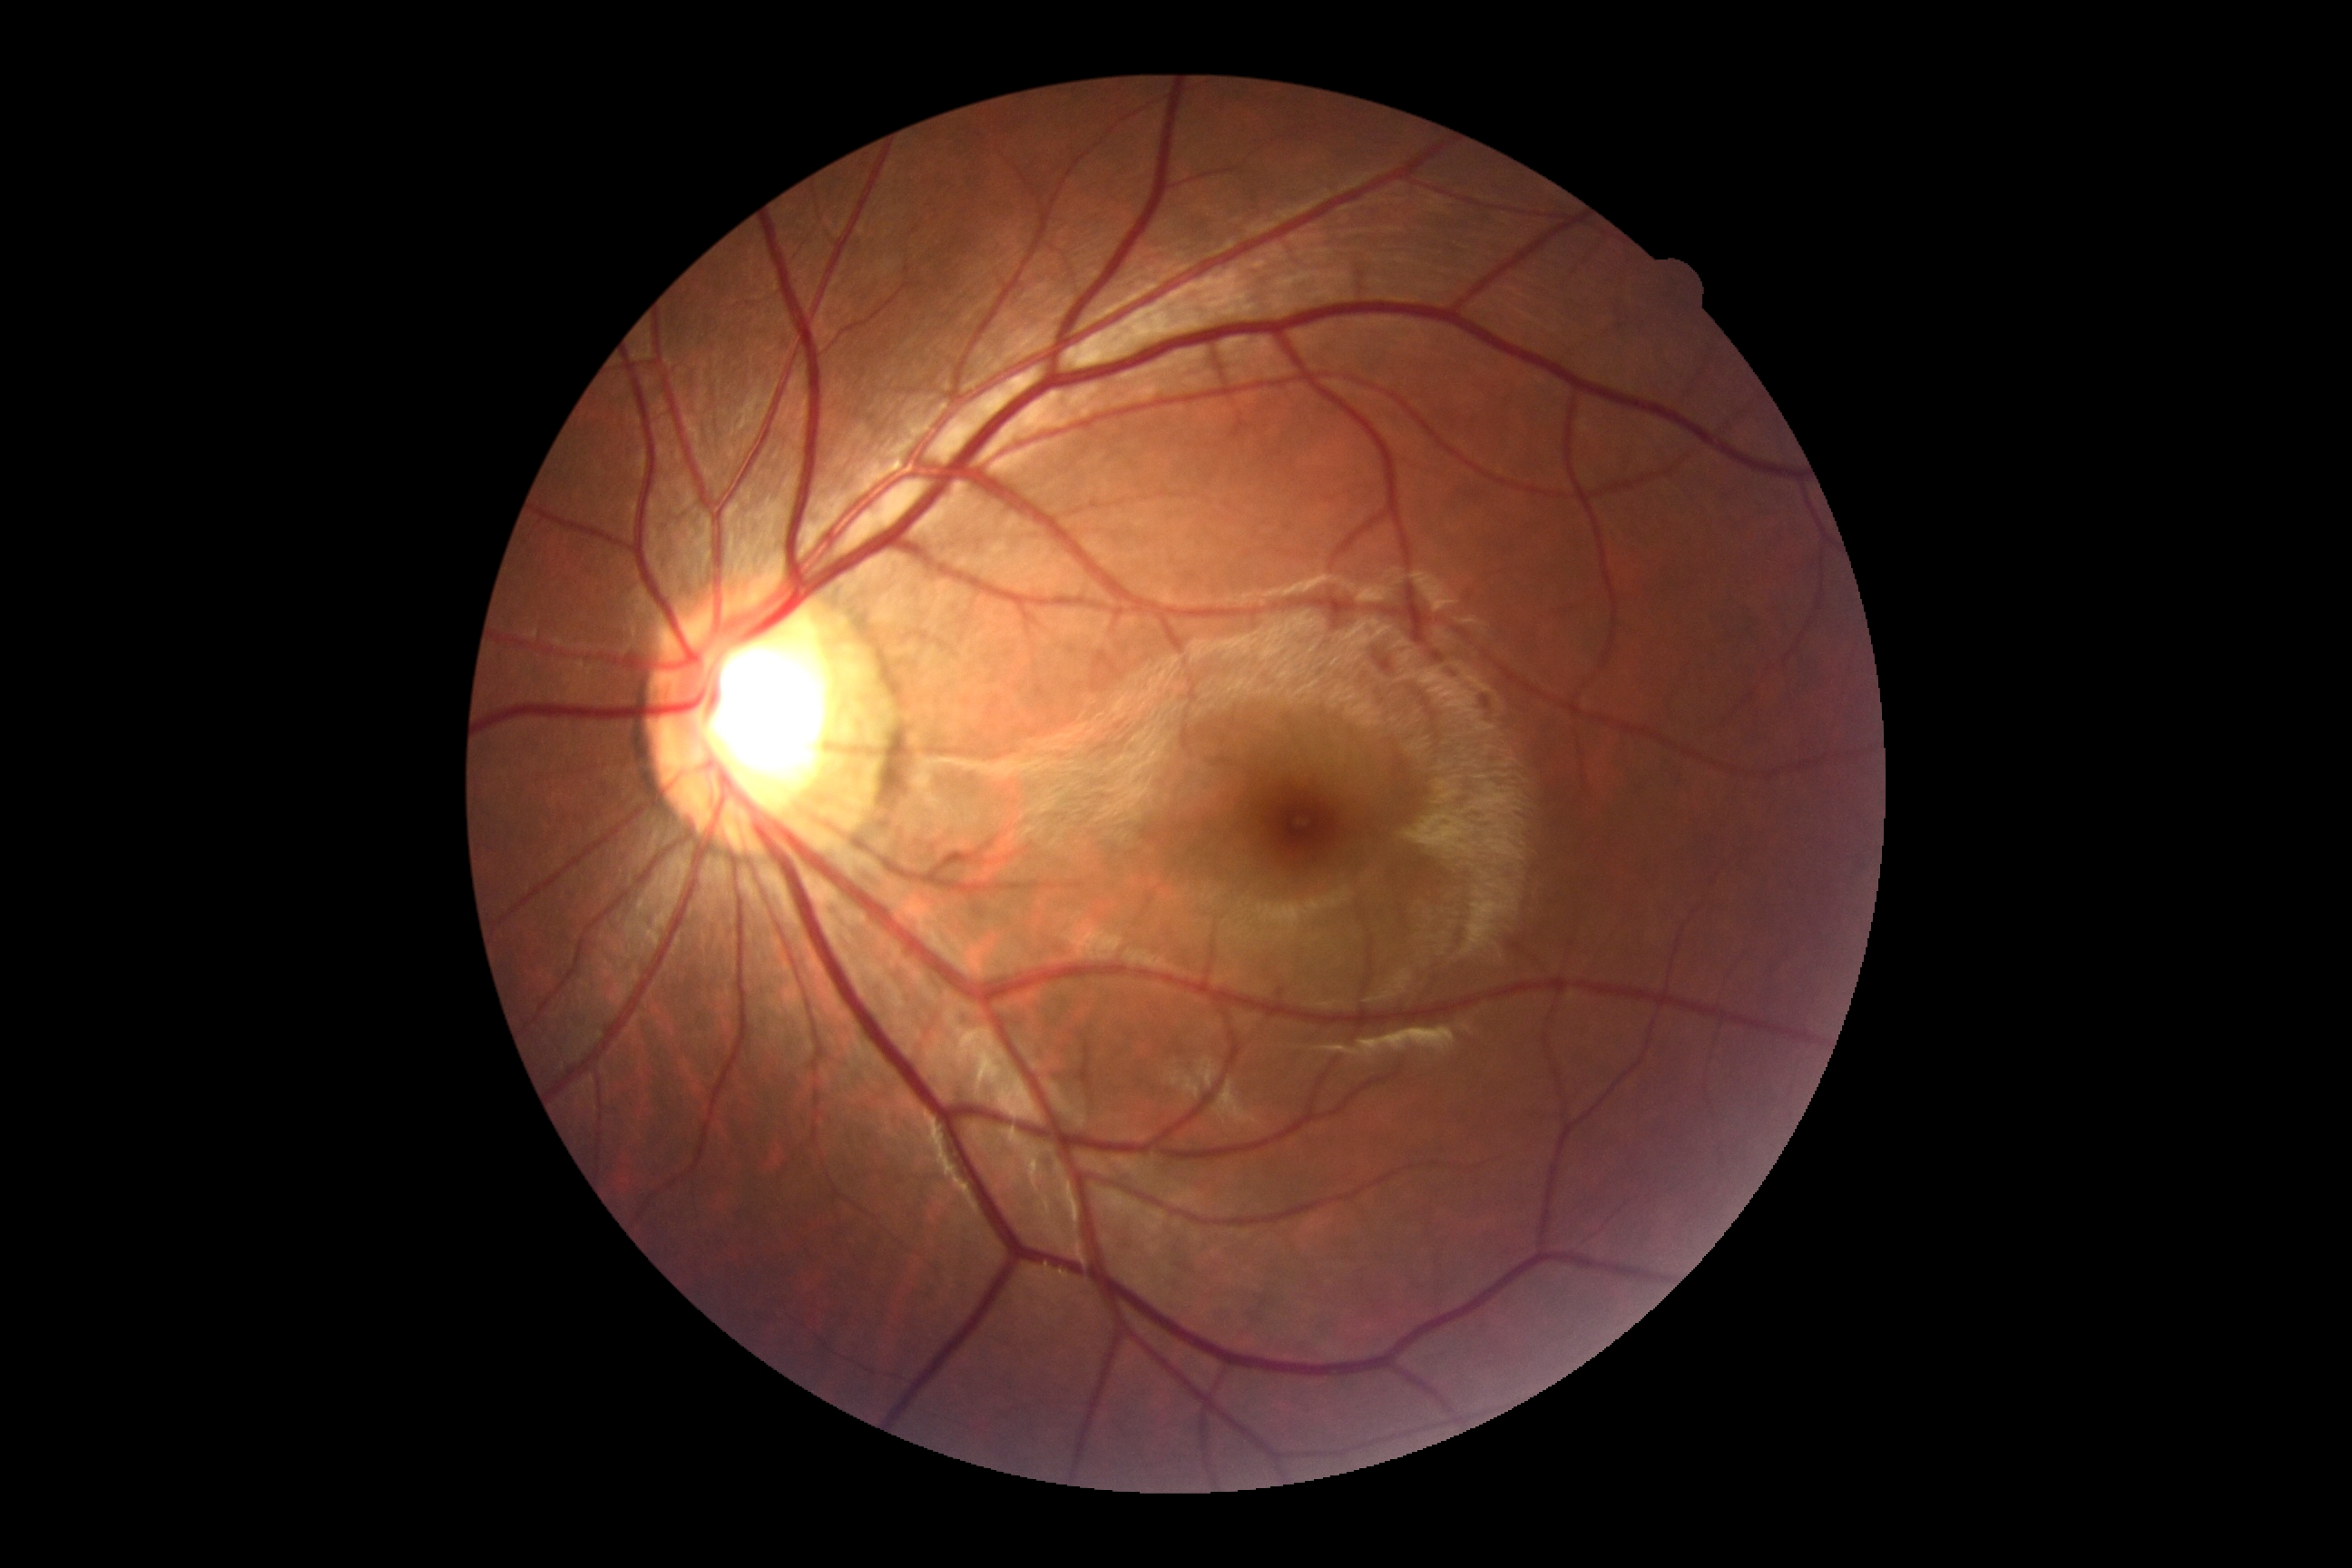

dr_grade: grade 0